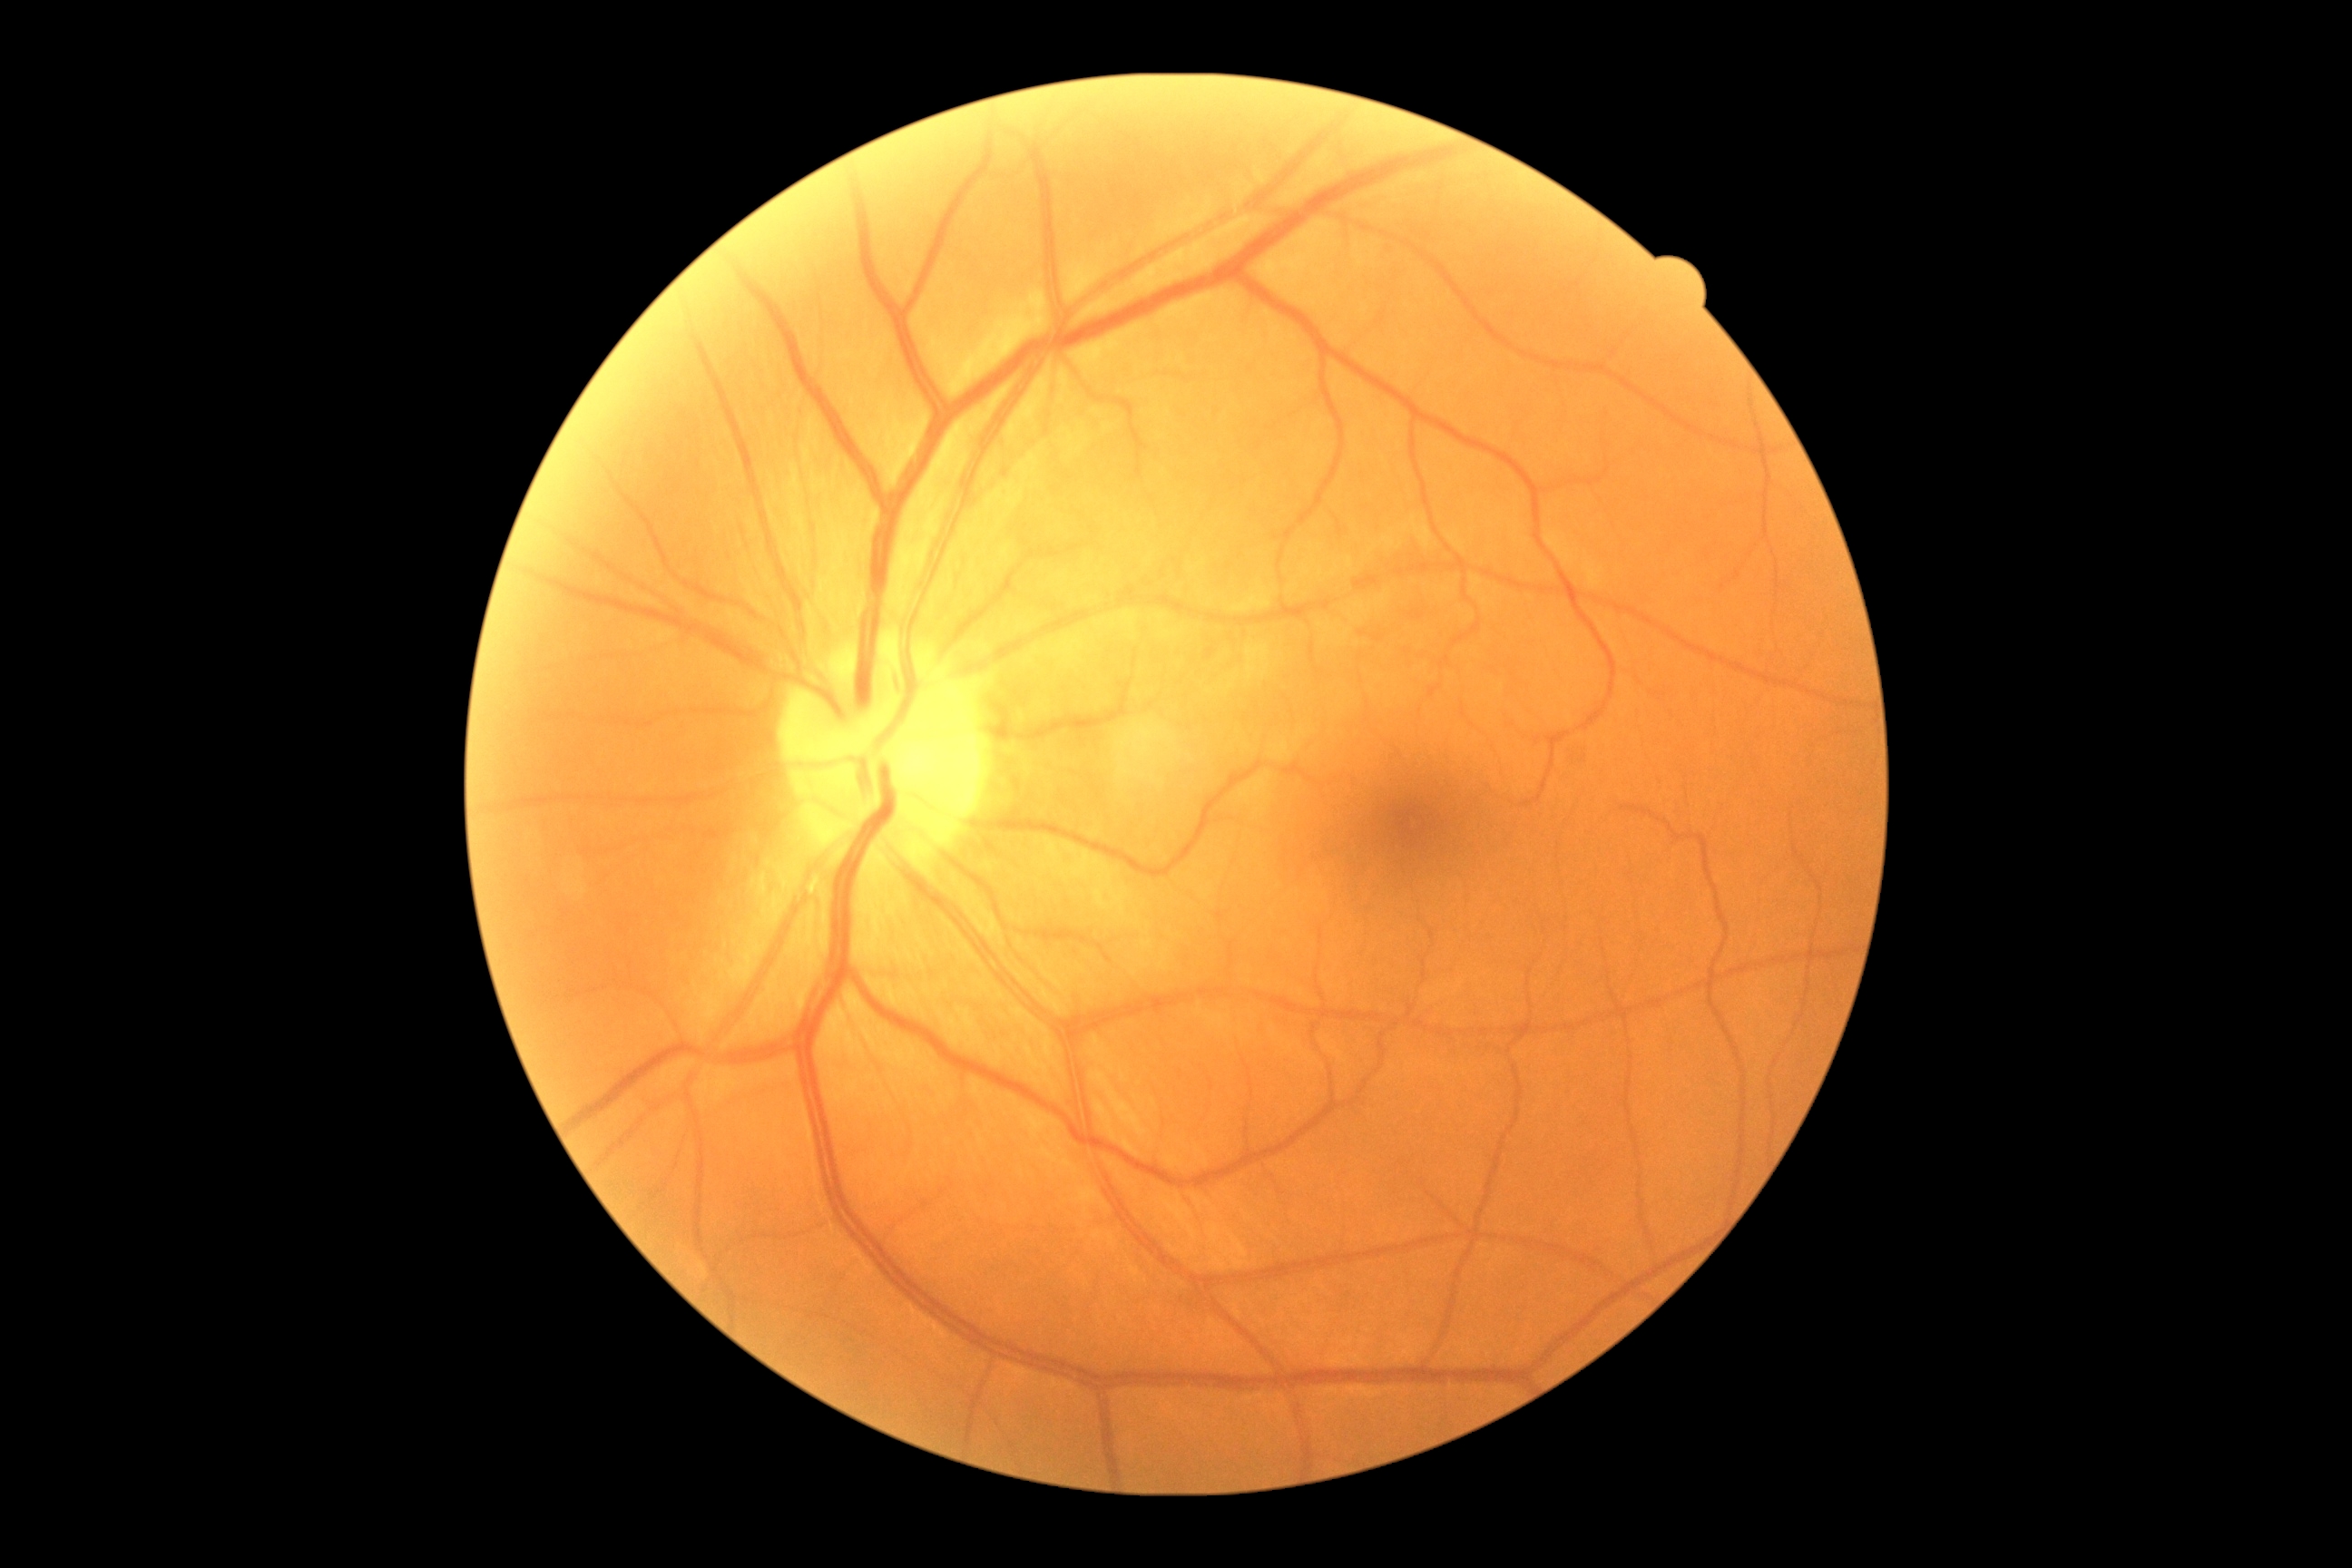
Diabetic retinopathy is no apparent retinopathy (grade 0).